Topcon TRC-50DX · 50-degree field of view · 2228 by 1652 pixels: 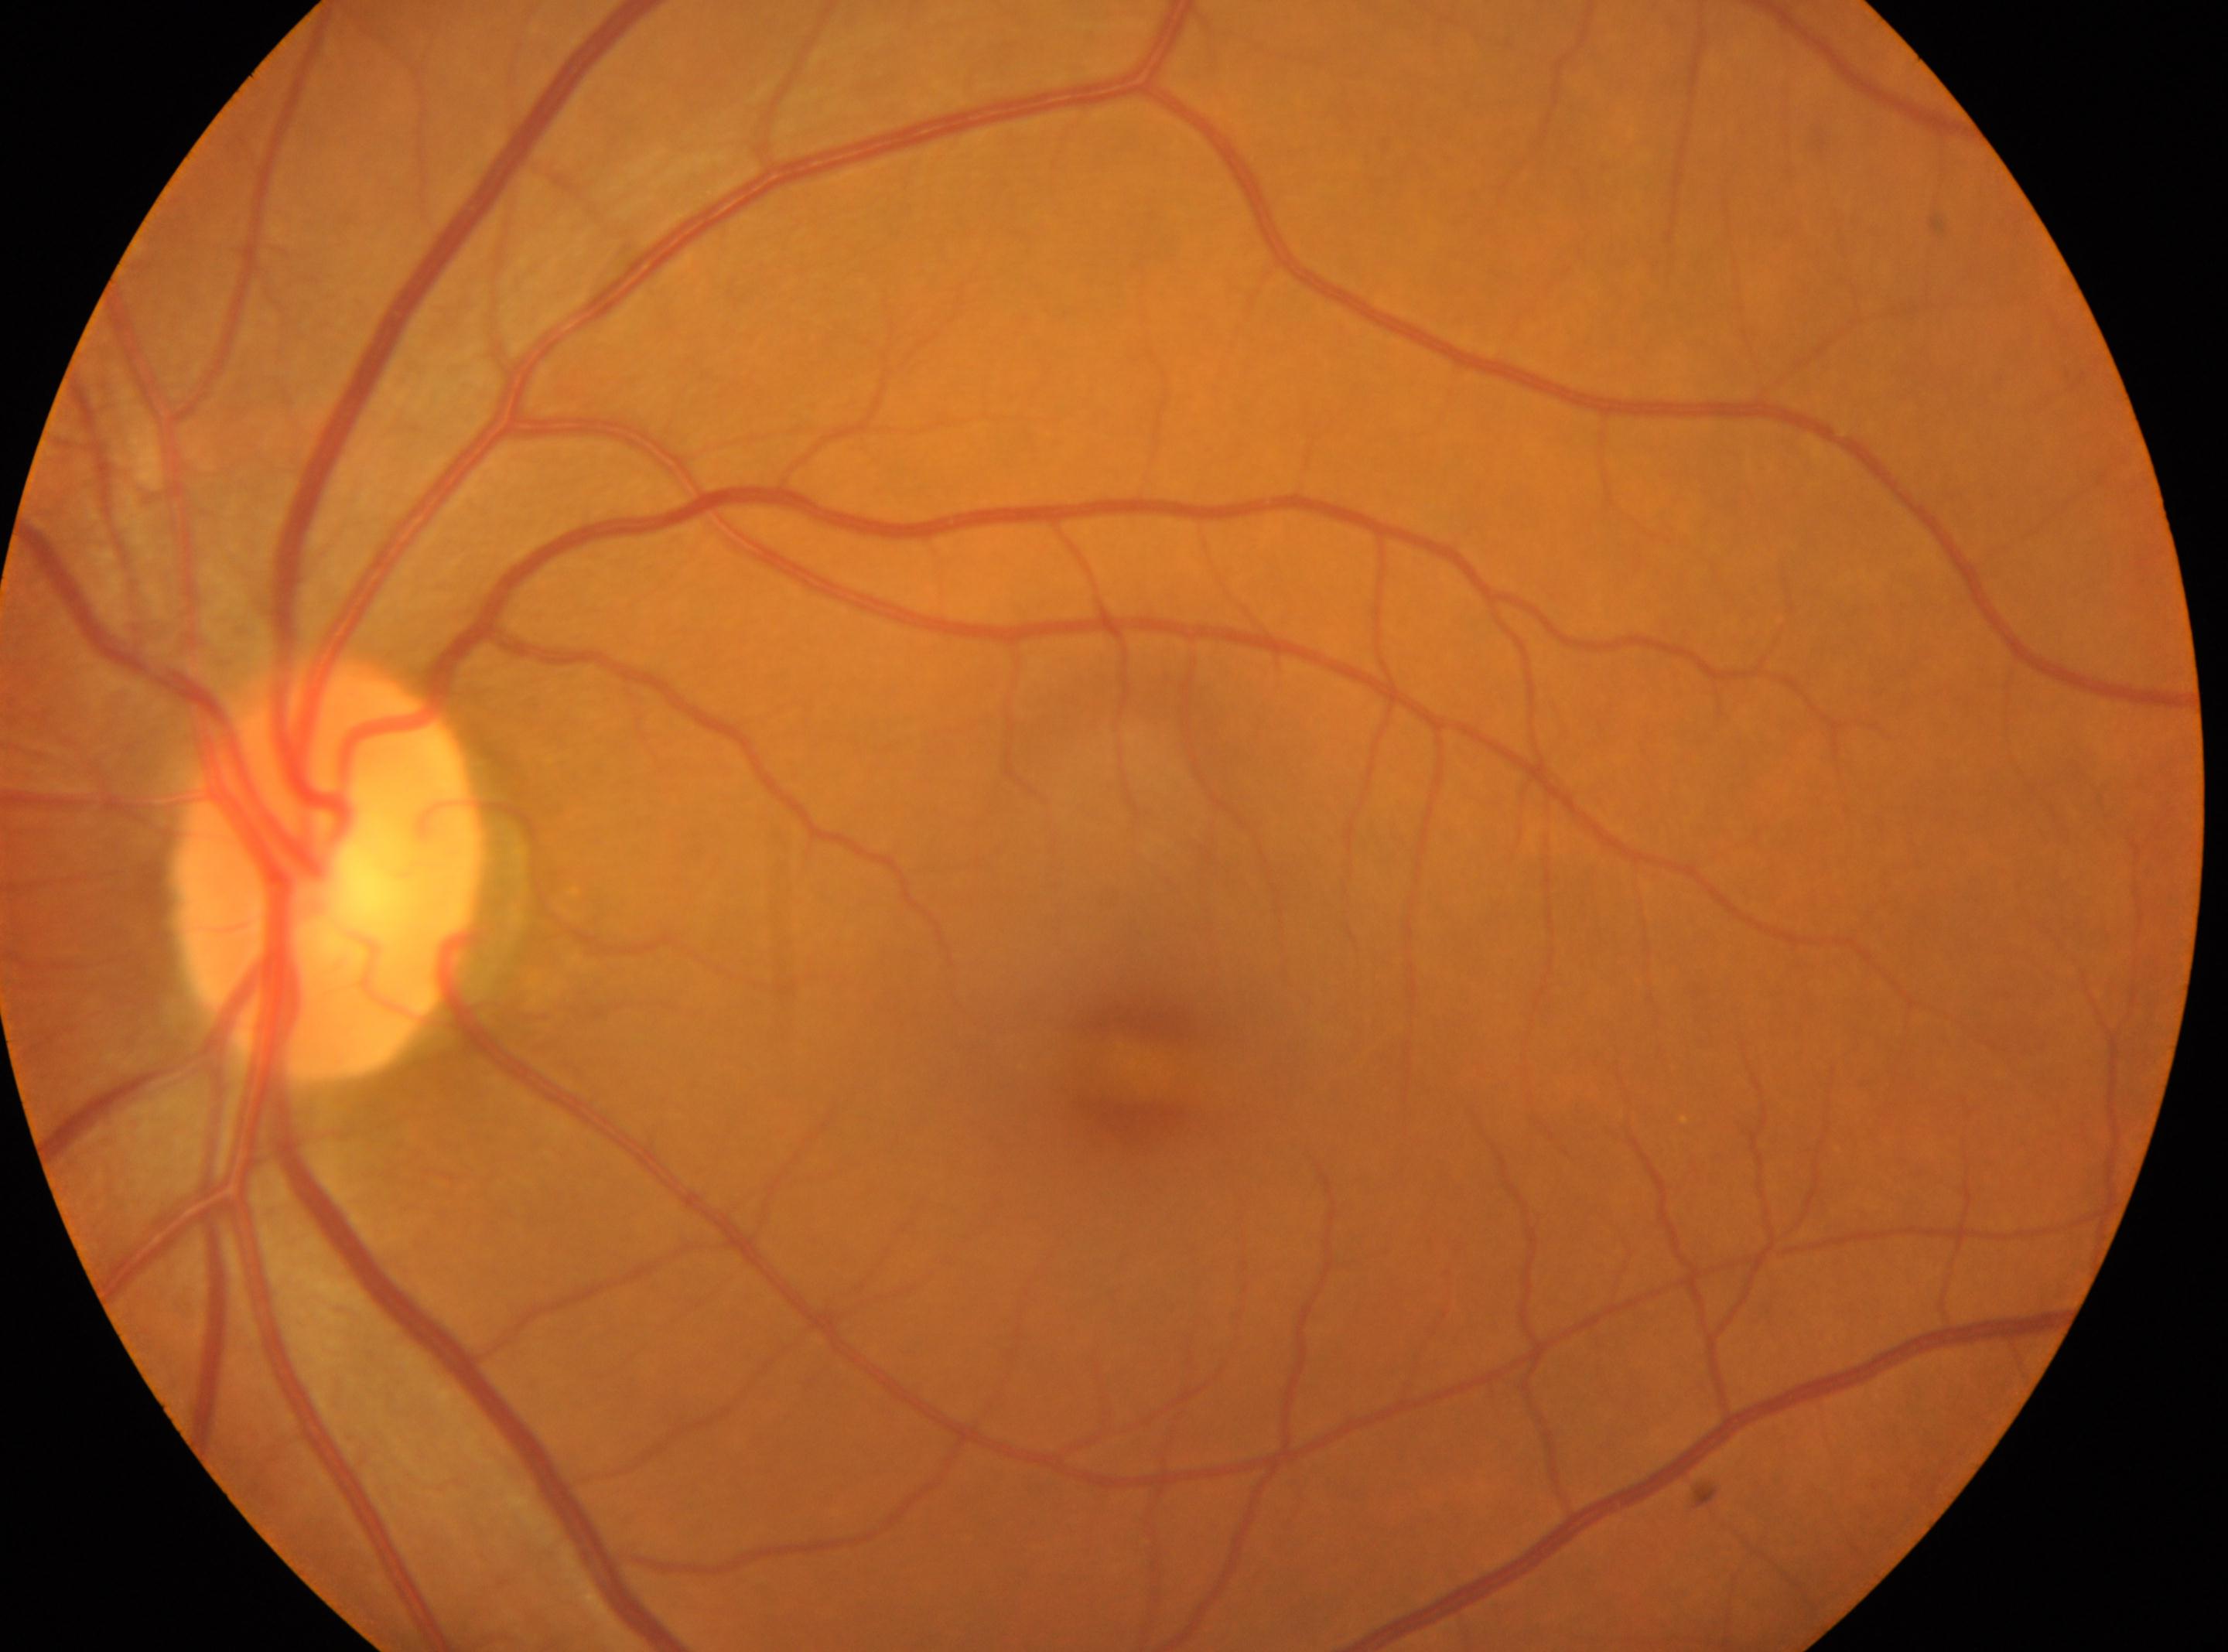
The fovea center is at (x=1131, y=1066). This is the oculus sinister. No diabetic retinal disease findings. Diabetic retinopathy is 0 — no visible signs of diabetic retinopathy. The optic disk is at (x=325, y=866).